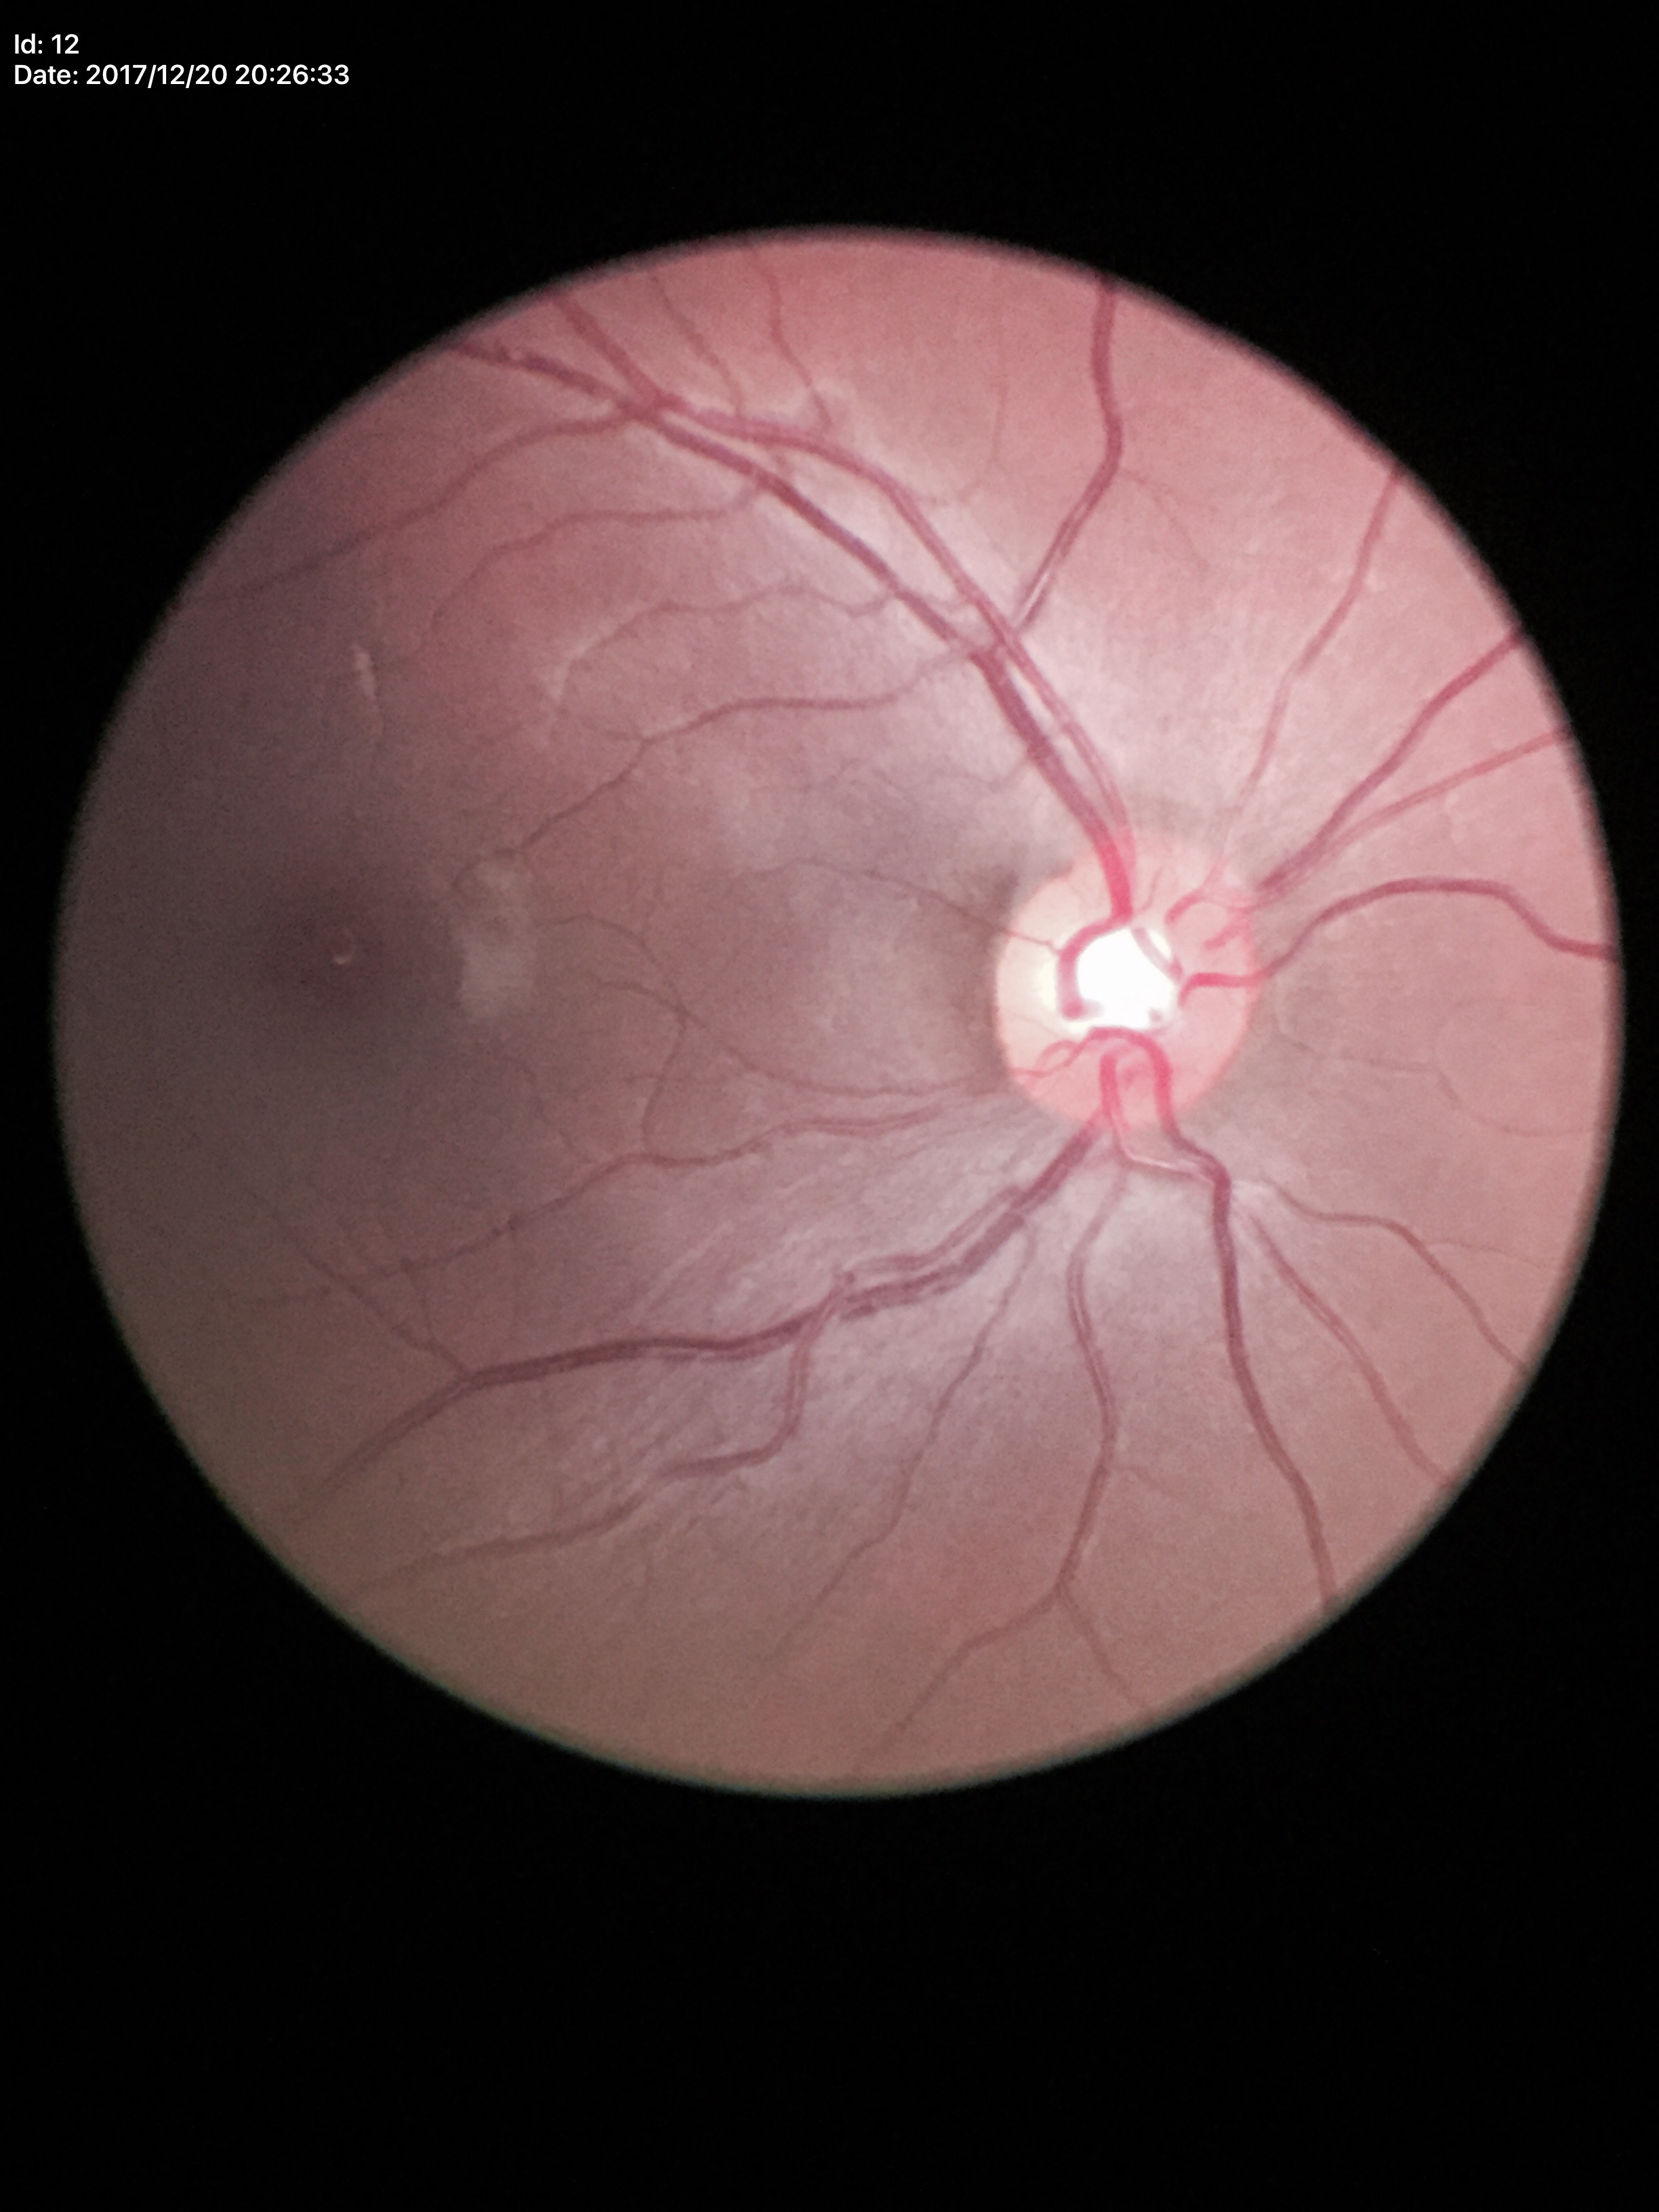

No signs of glaucoma.
Horizontal C/D ratio: 0.56.
Vertical CDR: 0.52.